1932 by 1910 pixels · 45° field of view · fundus photo
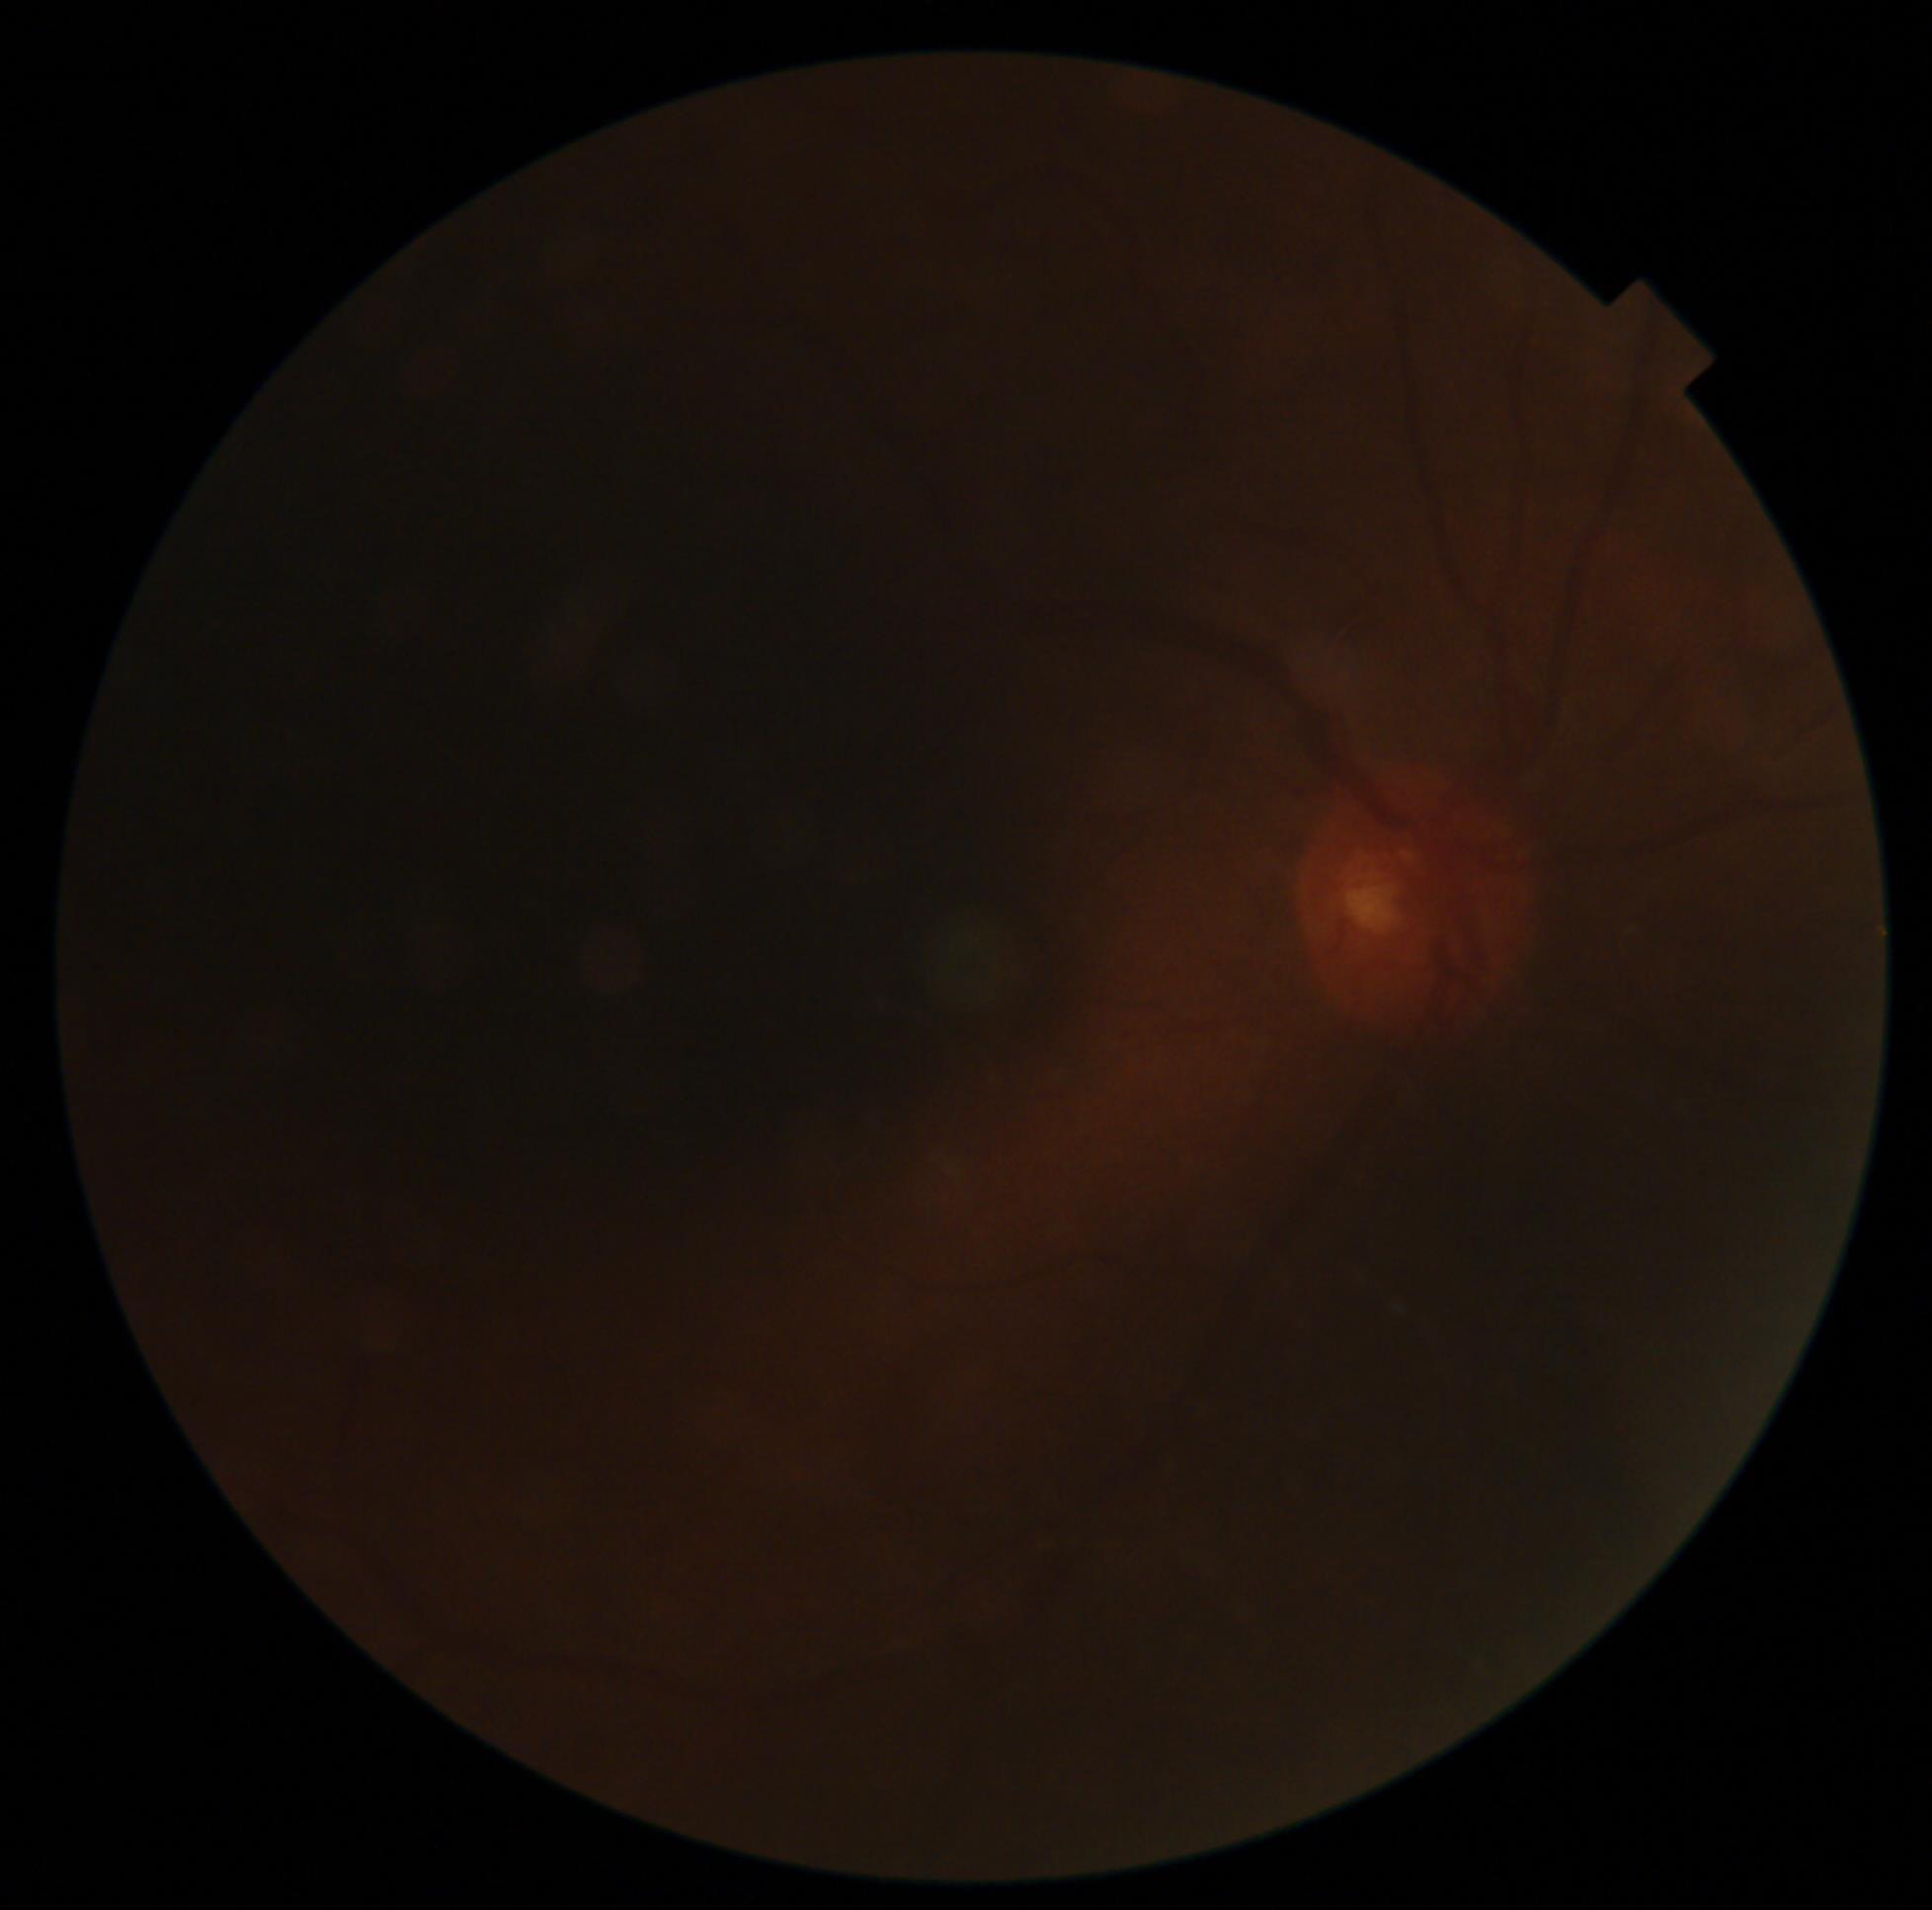 Retinopathy grade: ungradable.